NIDEK AFC-230 fundus camera — 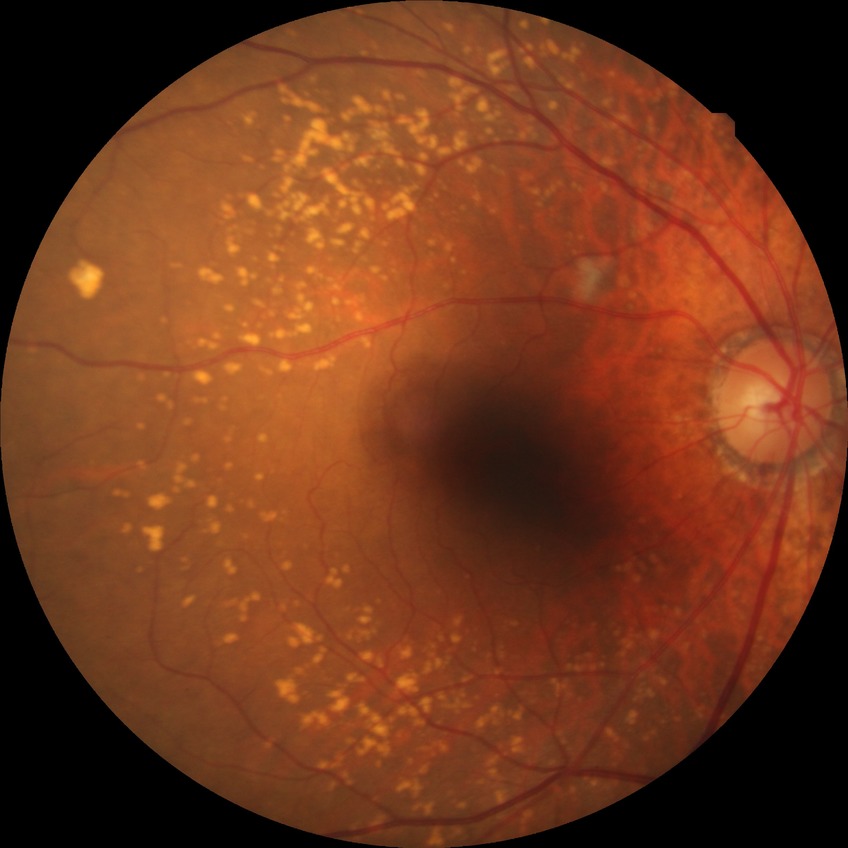 diabetic retinopathy (DR) = no diabetic retinopathy (NDR).